45 degree fundus photograph, nonmydriatic, 848x848px
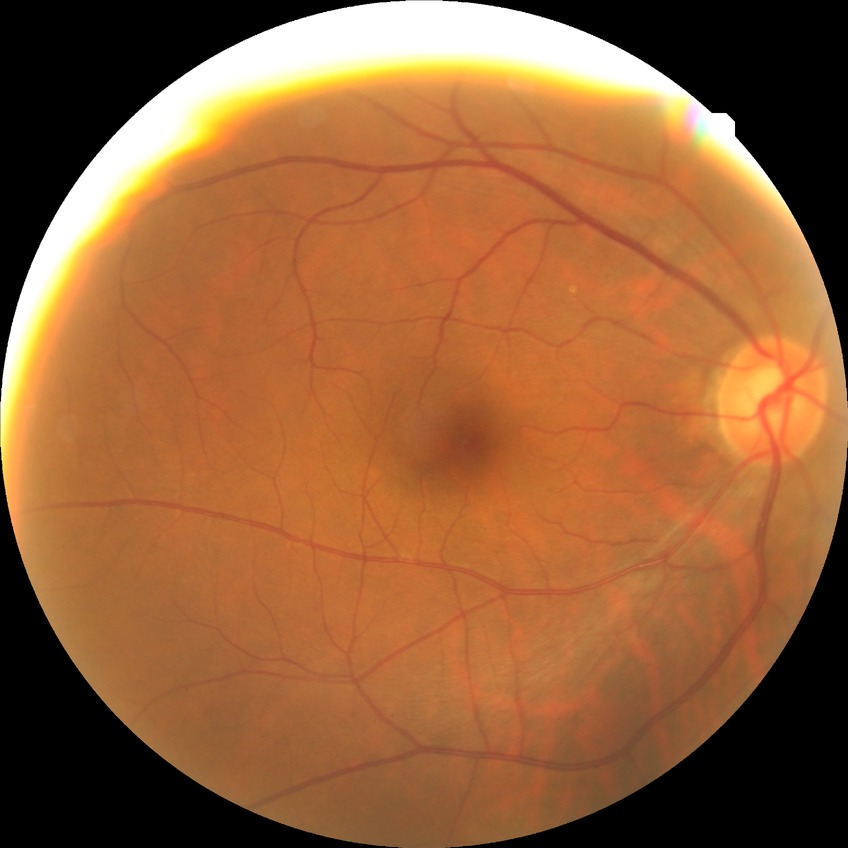 No apparent diabetic retinopathy. Davis DR grade is NDR.